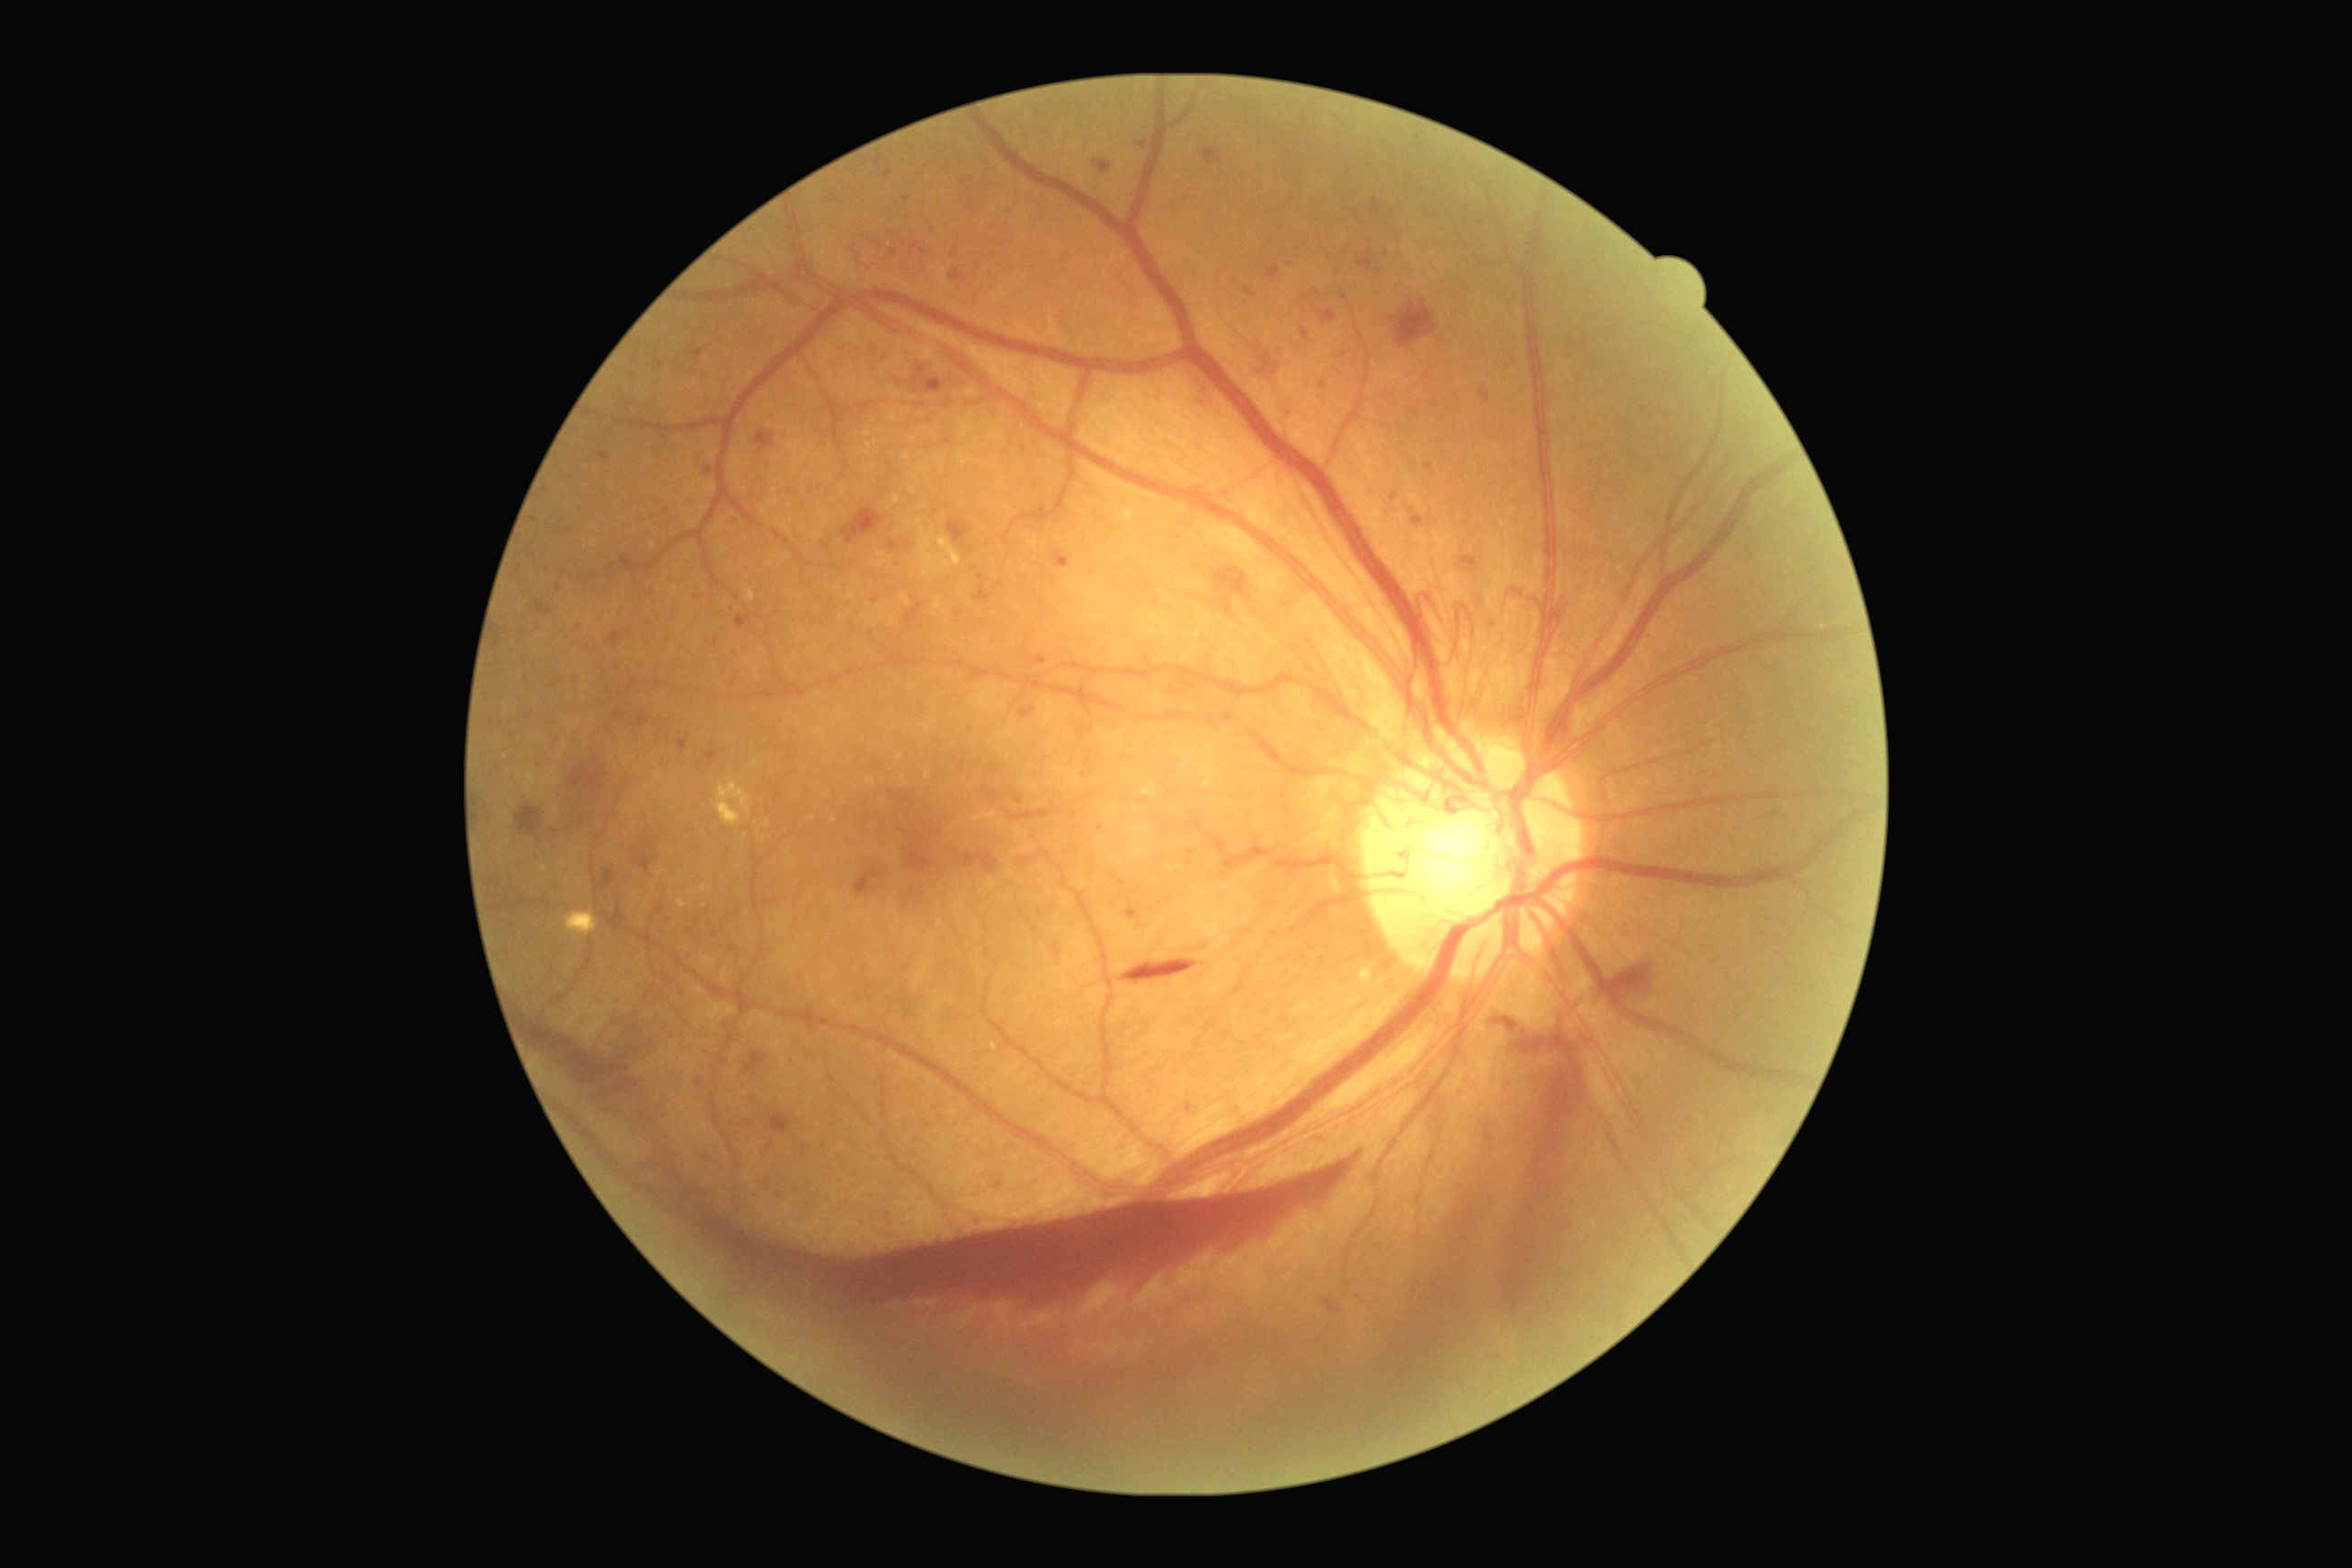
DR: 4
Selected lesions:
- MAs (partial): <region>678, 740, 689, 750</region>; <region>1338, 289, 1349, 302</region>; <region>1391, 210, 1396, 219</region>; <region>1037, 656, 1048, 665</region>; <region>1128, 908, 1141, 921</region>; <region>1188, 848, 1193, 856</region>; <region>534, 602, 553, 614</region>; <region>636, 716, 651, 729</region>; <region>714, 638, 720, 647</region>; <region>705, 743, 720, 763</region>
- Additional small MAs near [x=931, y=422]; [x=875, y=601]; [x=535, y=521]; [x=736, y=522]; [x=700, y=1082]; [x=1493, y=624]